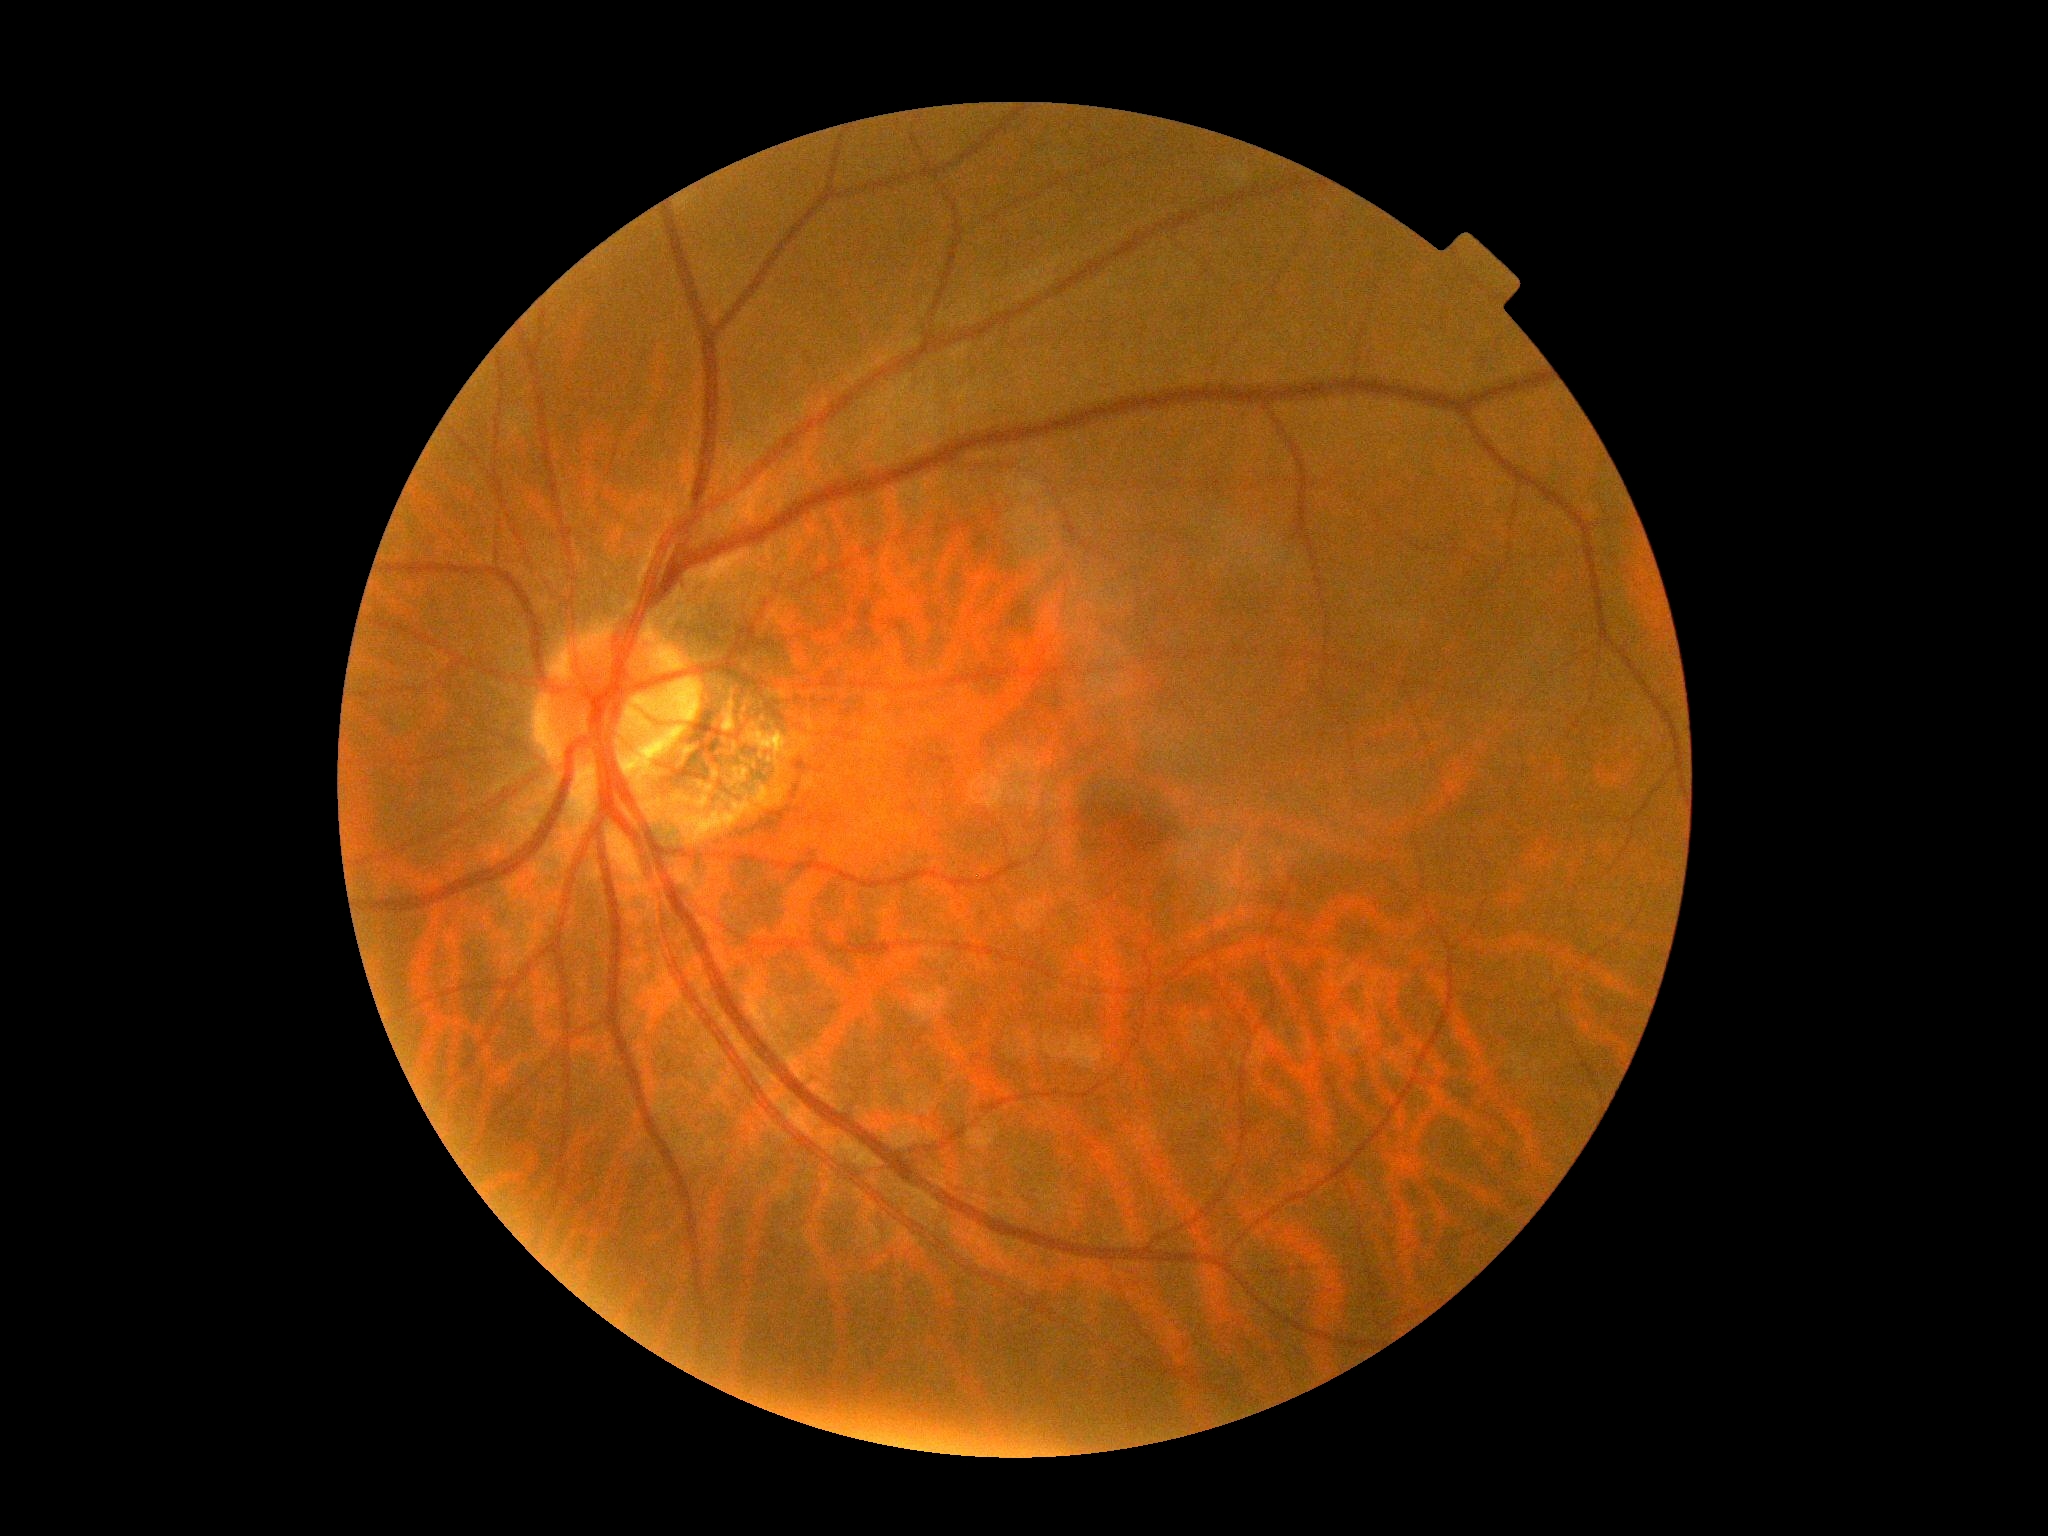
No apparent diabetic retinopathy.
Retinopathy is grade 0.